Color fundus photograph, 45° field of view, 2352 x 1568 pixels — 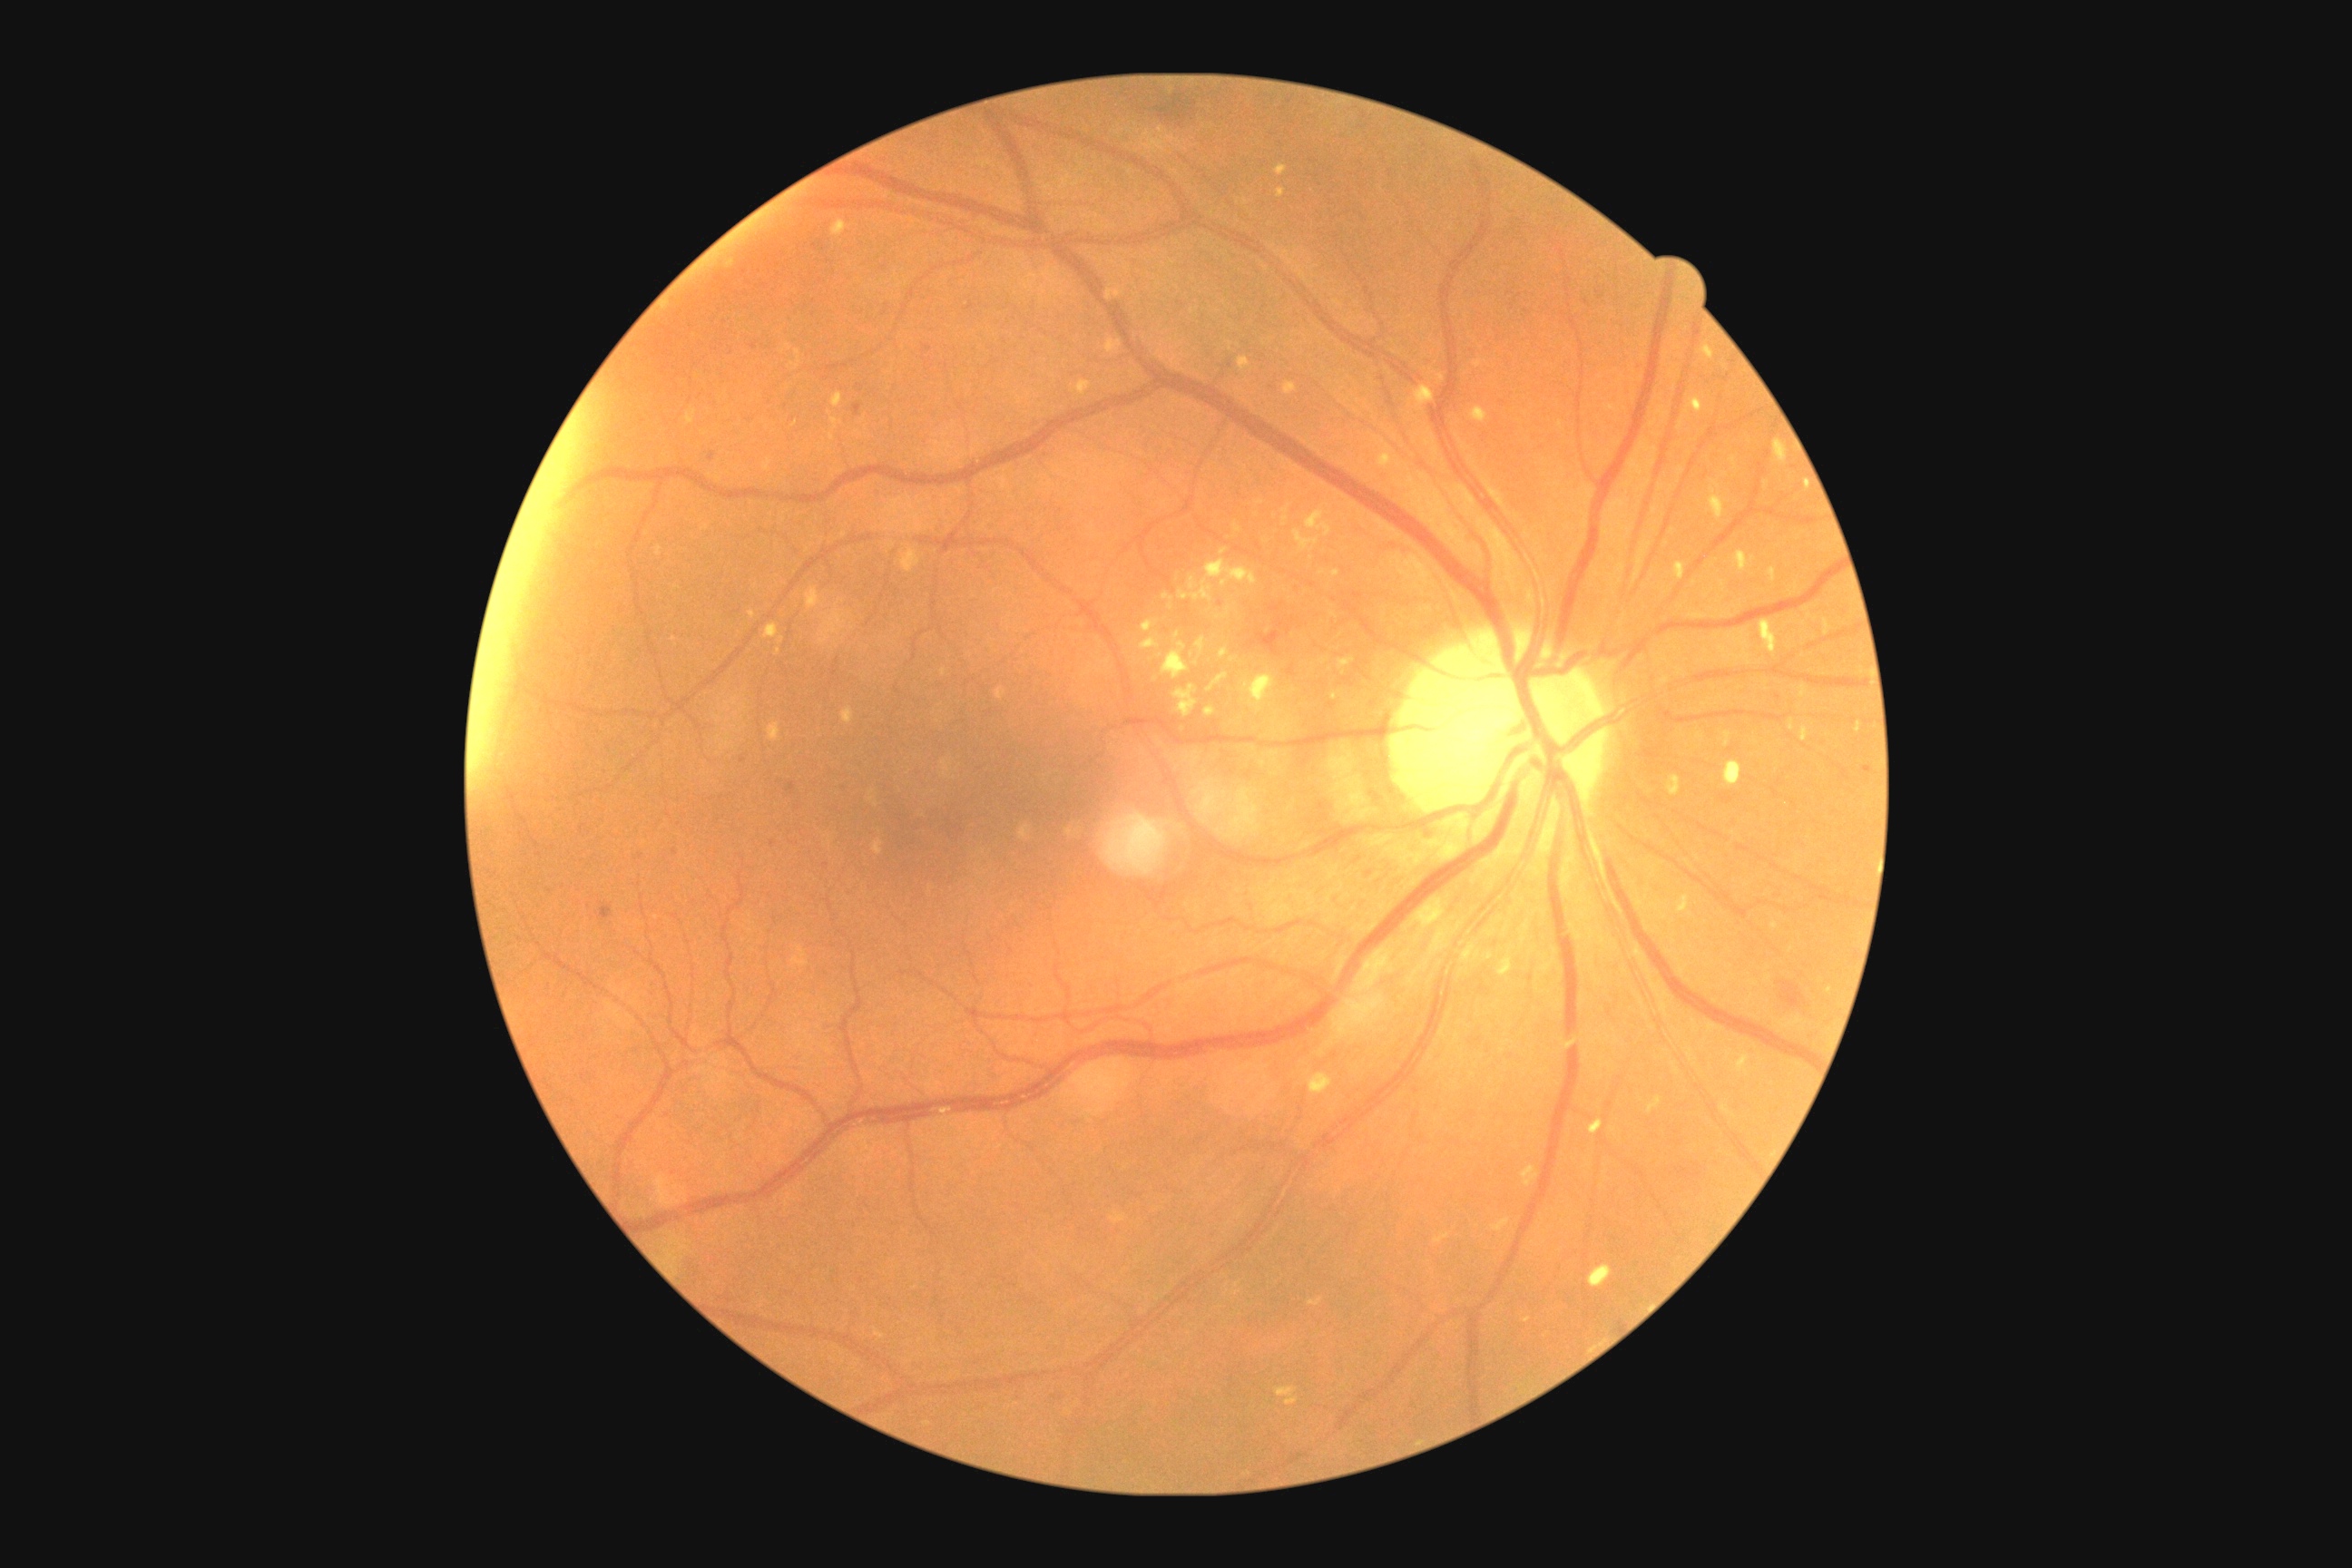

Diabetic retinopathy (DR): 2/4 — more than just microaneurysms but less than severe NPDR
Selected lesions:
• hard exudates (EXs): none
• hemorrhages (HEs) (continued): box=[1157, 106, 1175, 119]; box=[1778, 981, 1808, 1008]; box=[1173, 93, 1190, 113]
• HEs (small, approximate centers) near [x=1194, y=103]
• soft exudates (SEs) (continued): box=[1275, 164, 1288, 177]; box=[1175, 632, 1181, 640]; box=[1162, 593, 1173, 611]; box=[1162, 642, 1190, 680]; box=[1179, 564, 1257, 603]; box=[763, 623, 779, 640]; box=[1208, 672, 1230, 692]; box=[1277, 190, 1286, 199]; box=[1204, 707, 1217, 716]; box=[1685, 397, 1703, 413]
• SEs (small, approximate centers) near [x=1157, y=679]; [x=1218, y=618]
• microaneurysms (MAs) (continued): box=[1257, 631, 1282, 656]; box=[709, 453, 716, 462]; box=[672, 848, 678, 856]; box=[787, 781, 796, 794]; box=[600, 901, 612, 919]; box=[852, 404, 863, 416]
• MAs (small, approximate centers) near [x=744, y=760]; [x=773, y=844]; [x=928, y=349]